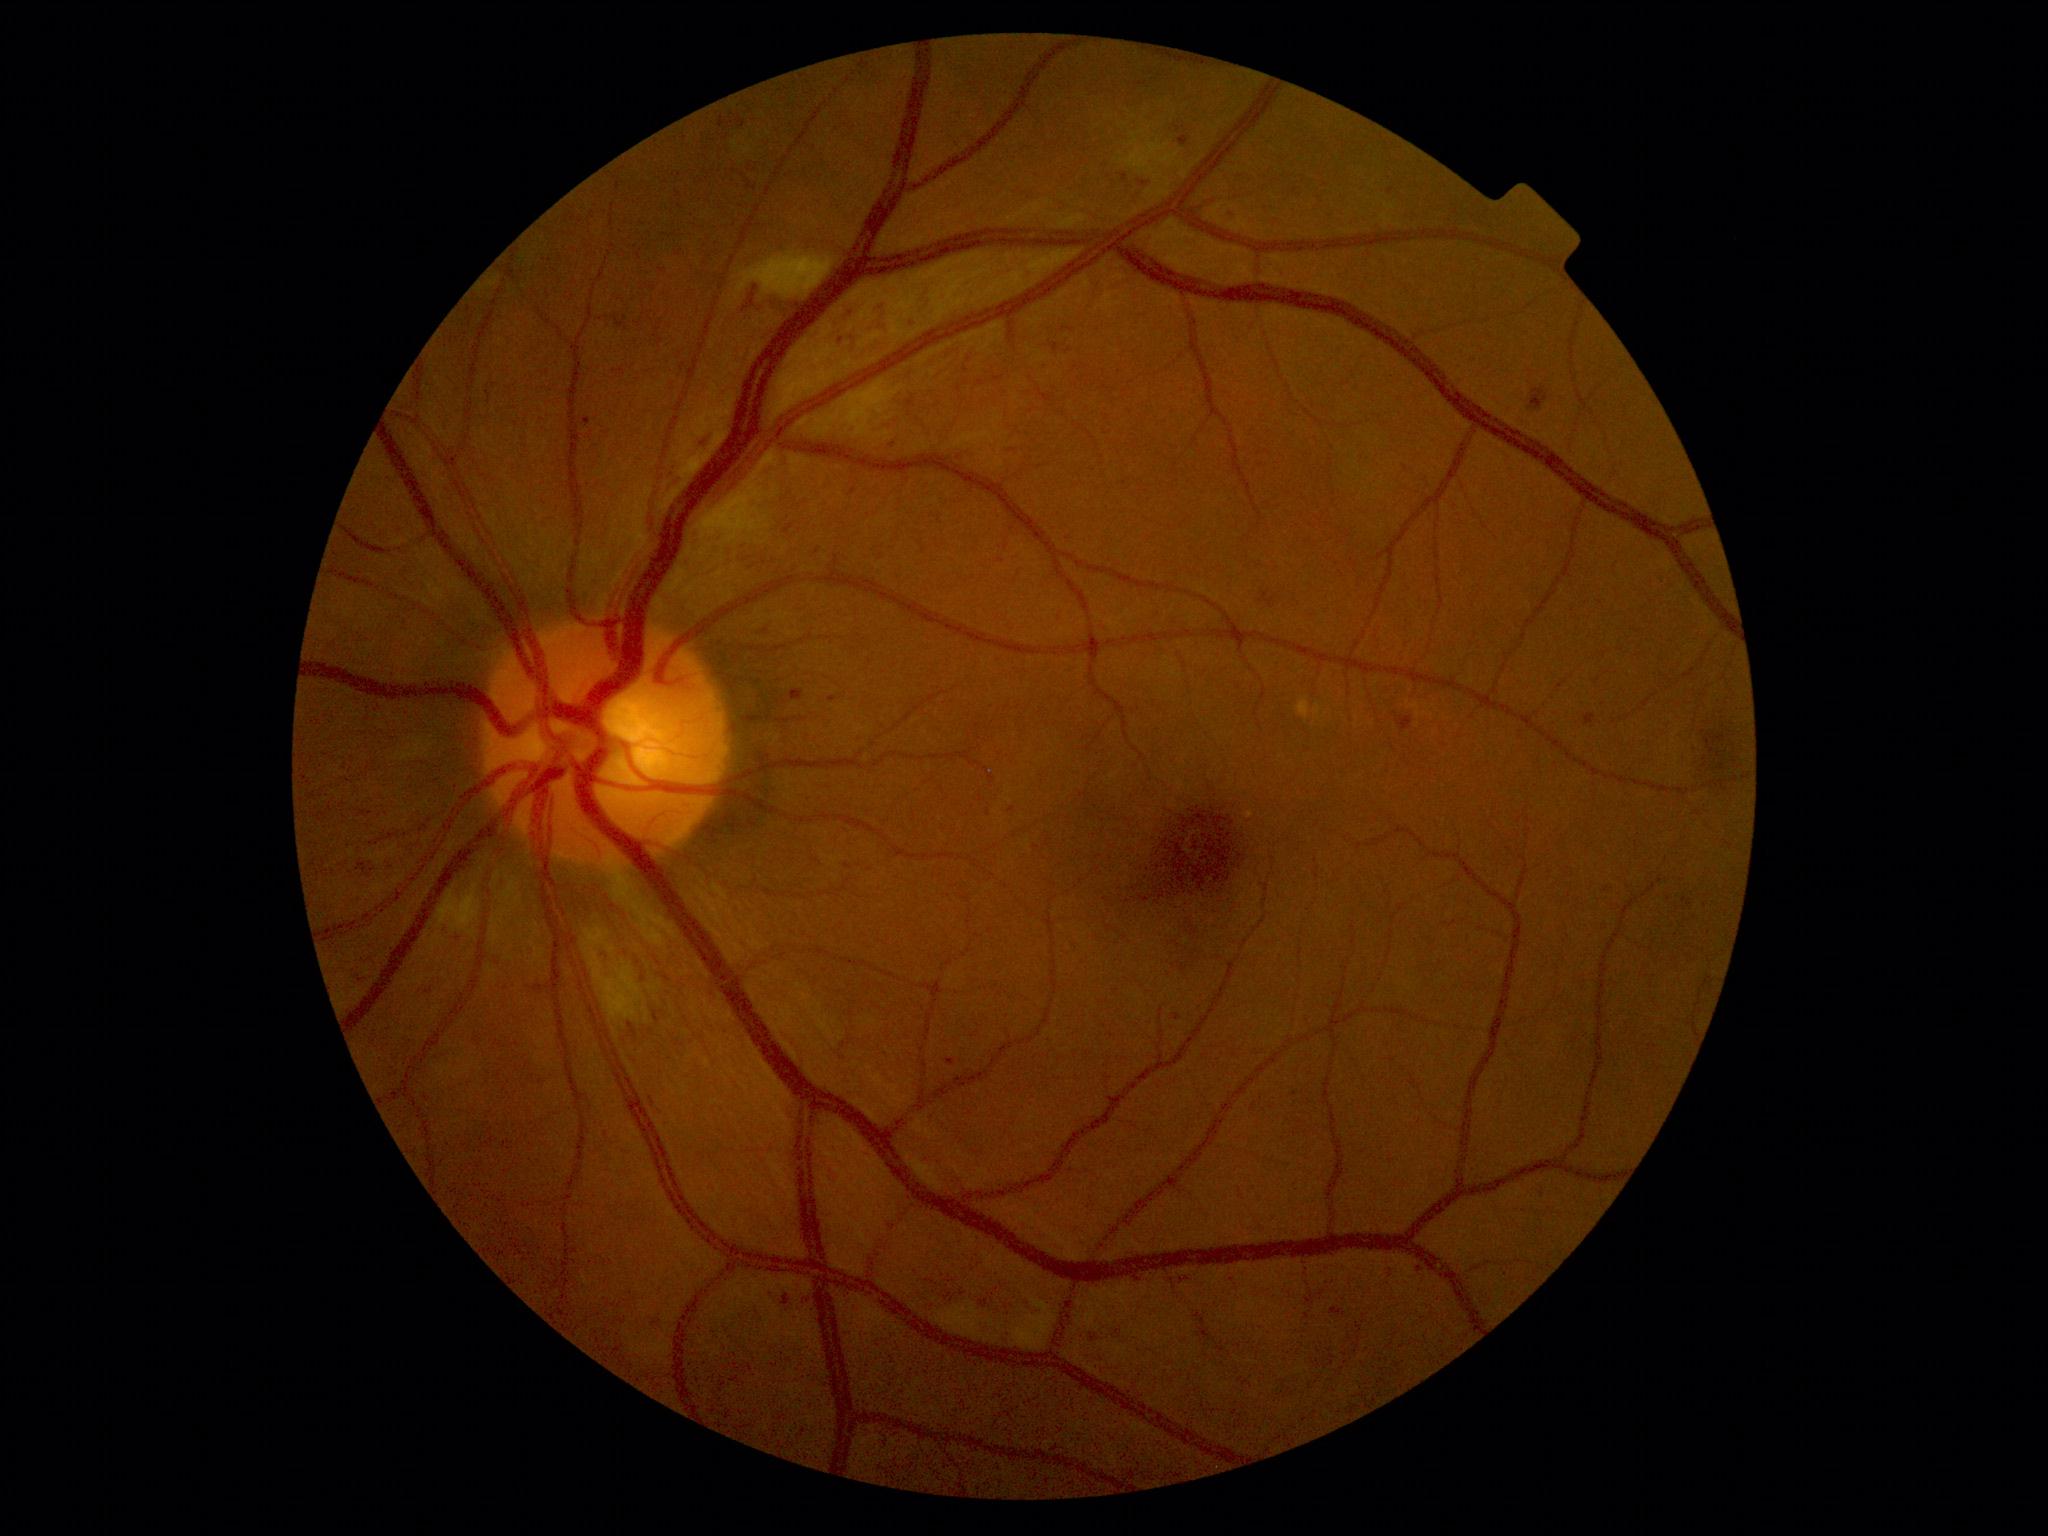
Diabetic retinopathy (DR): 2.